2048 by 1536 pixels:
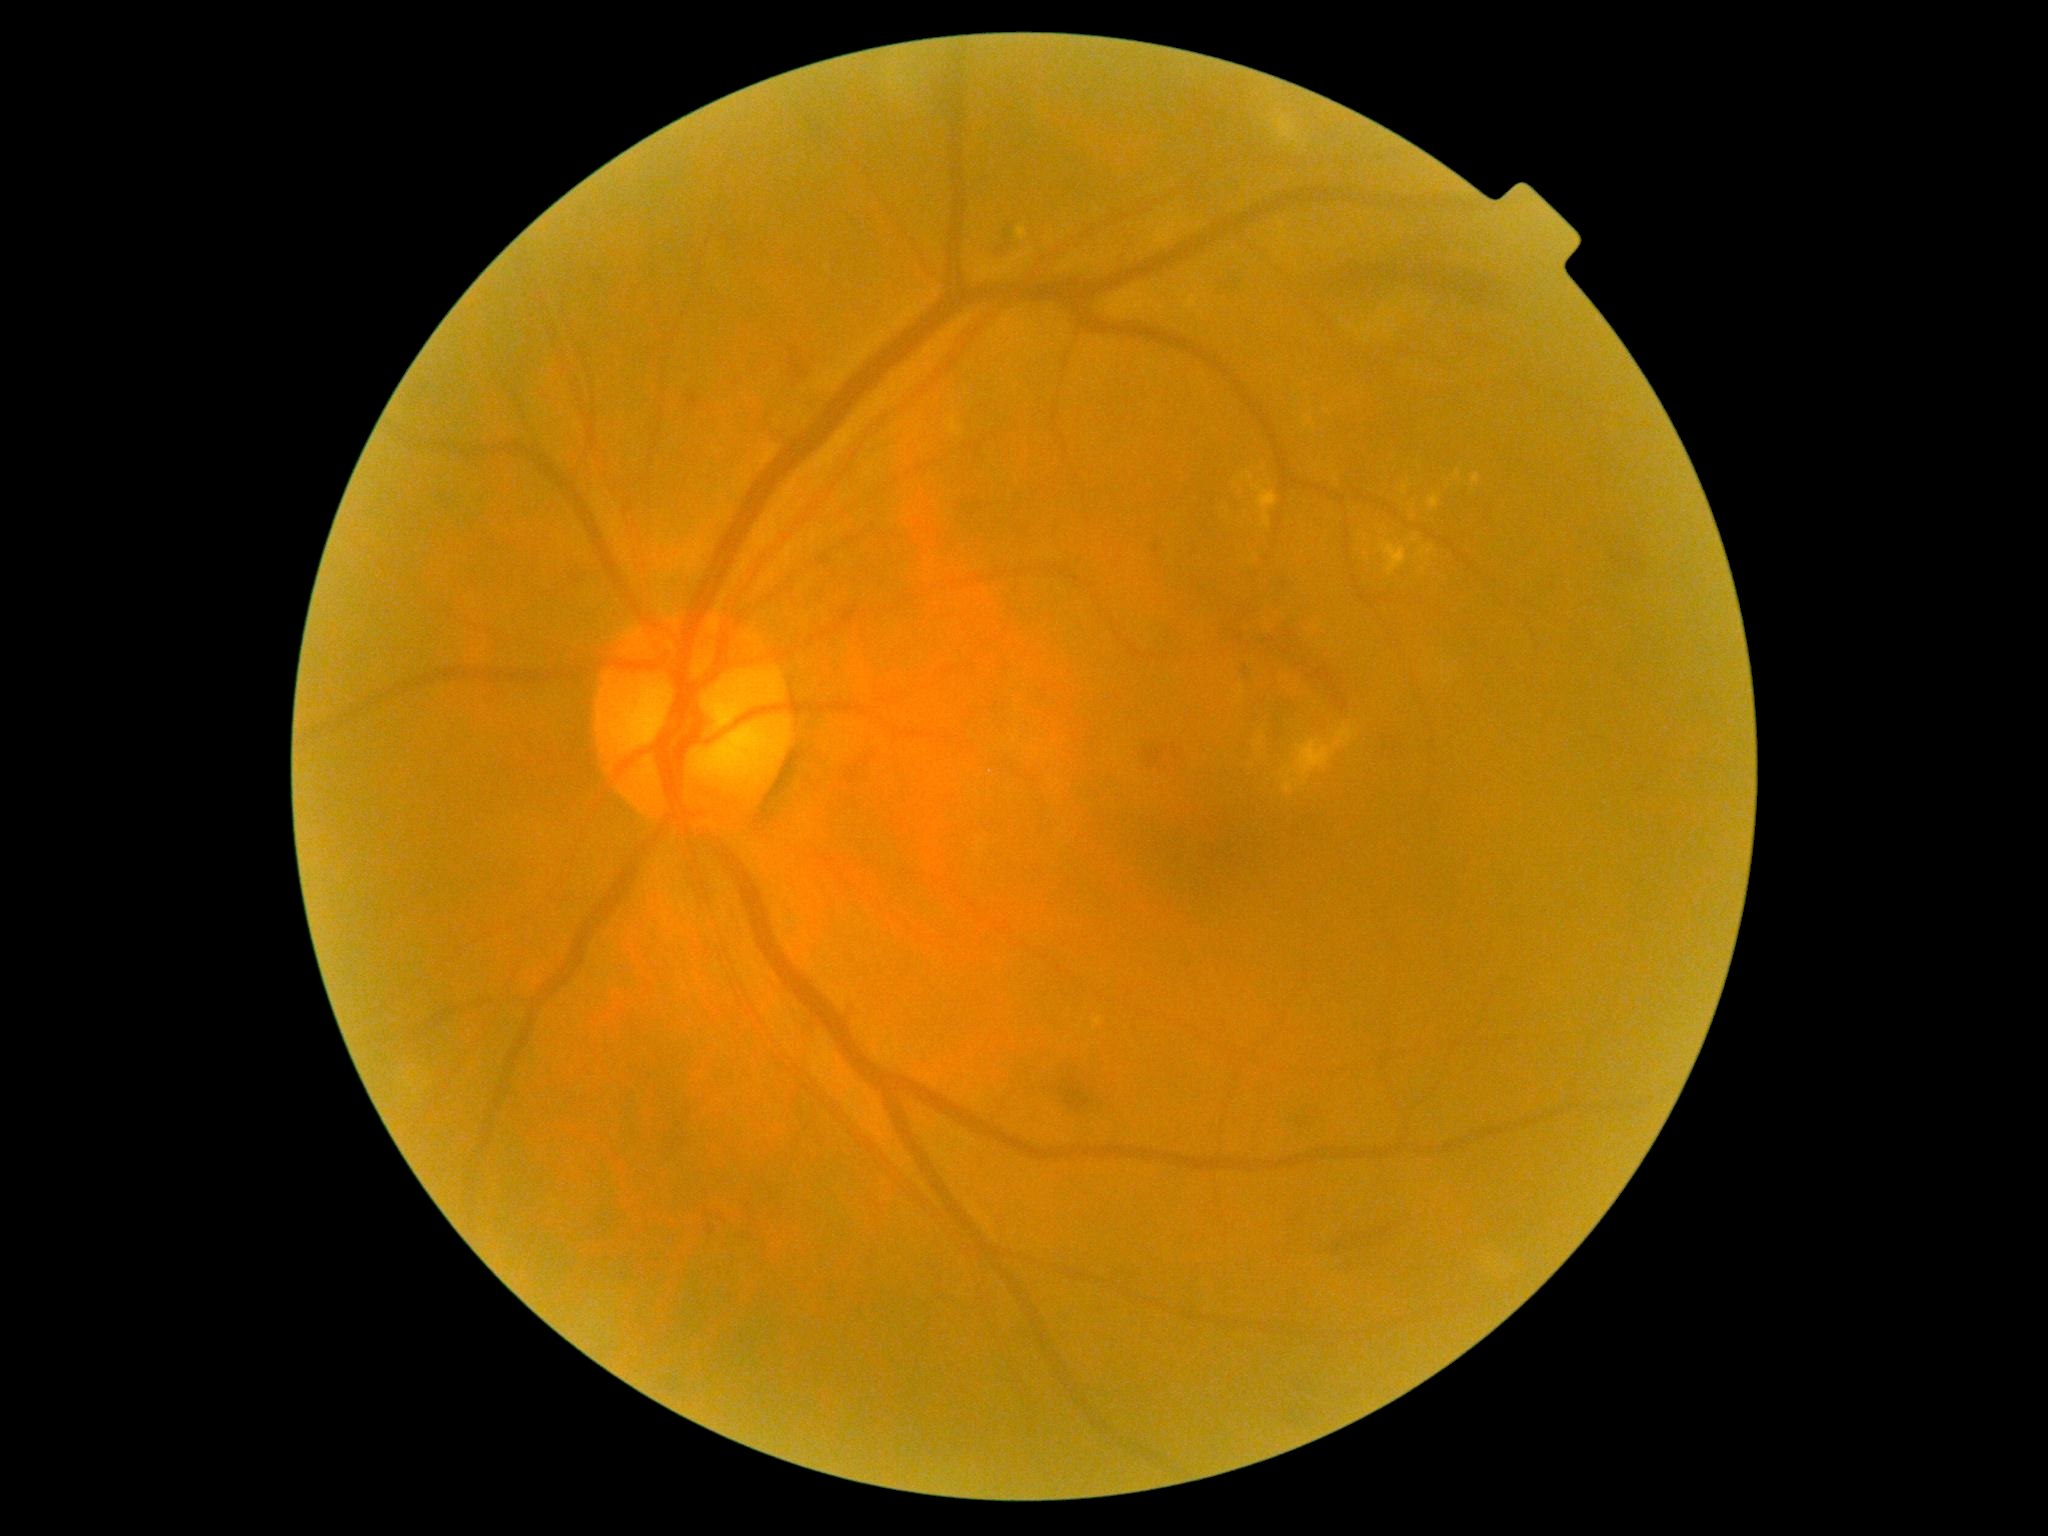 diabetic retinopathy (DR) = moderate NPDR (grade 2).